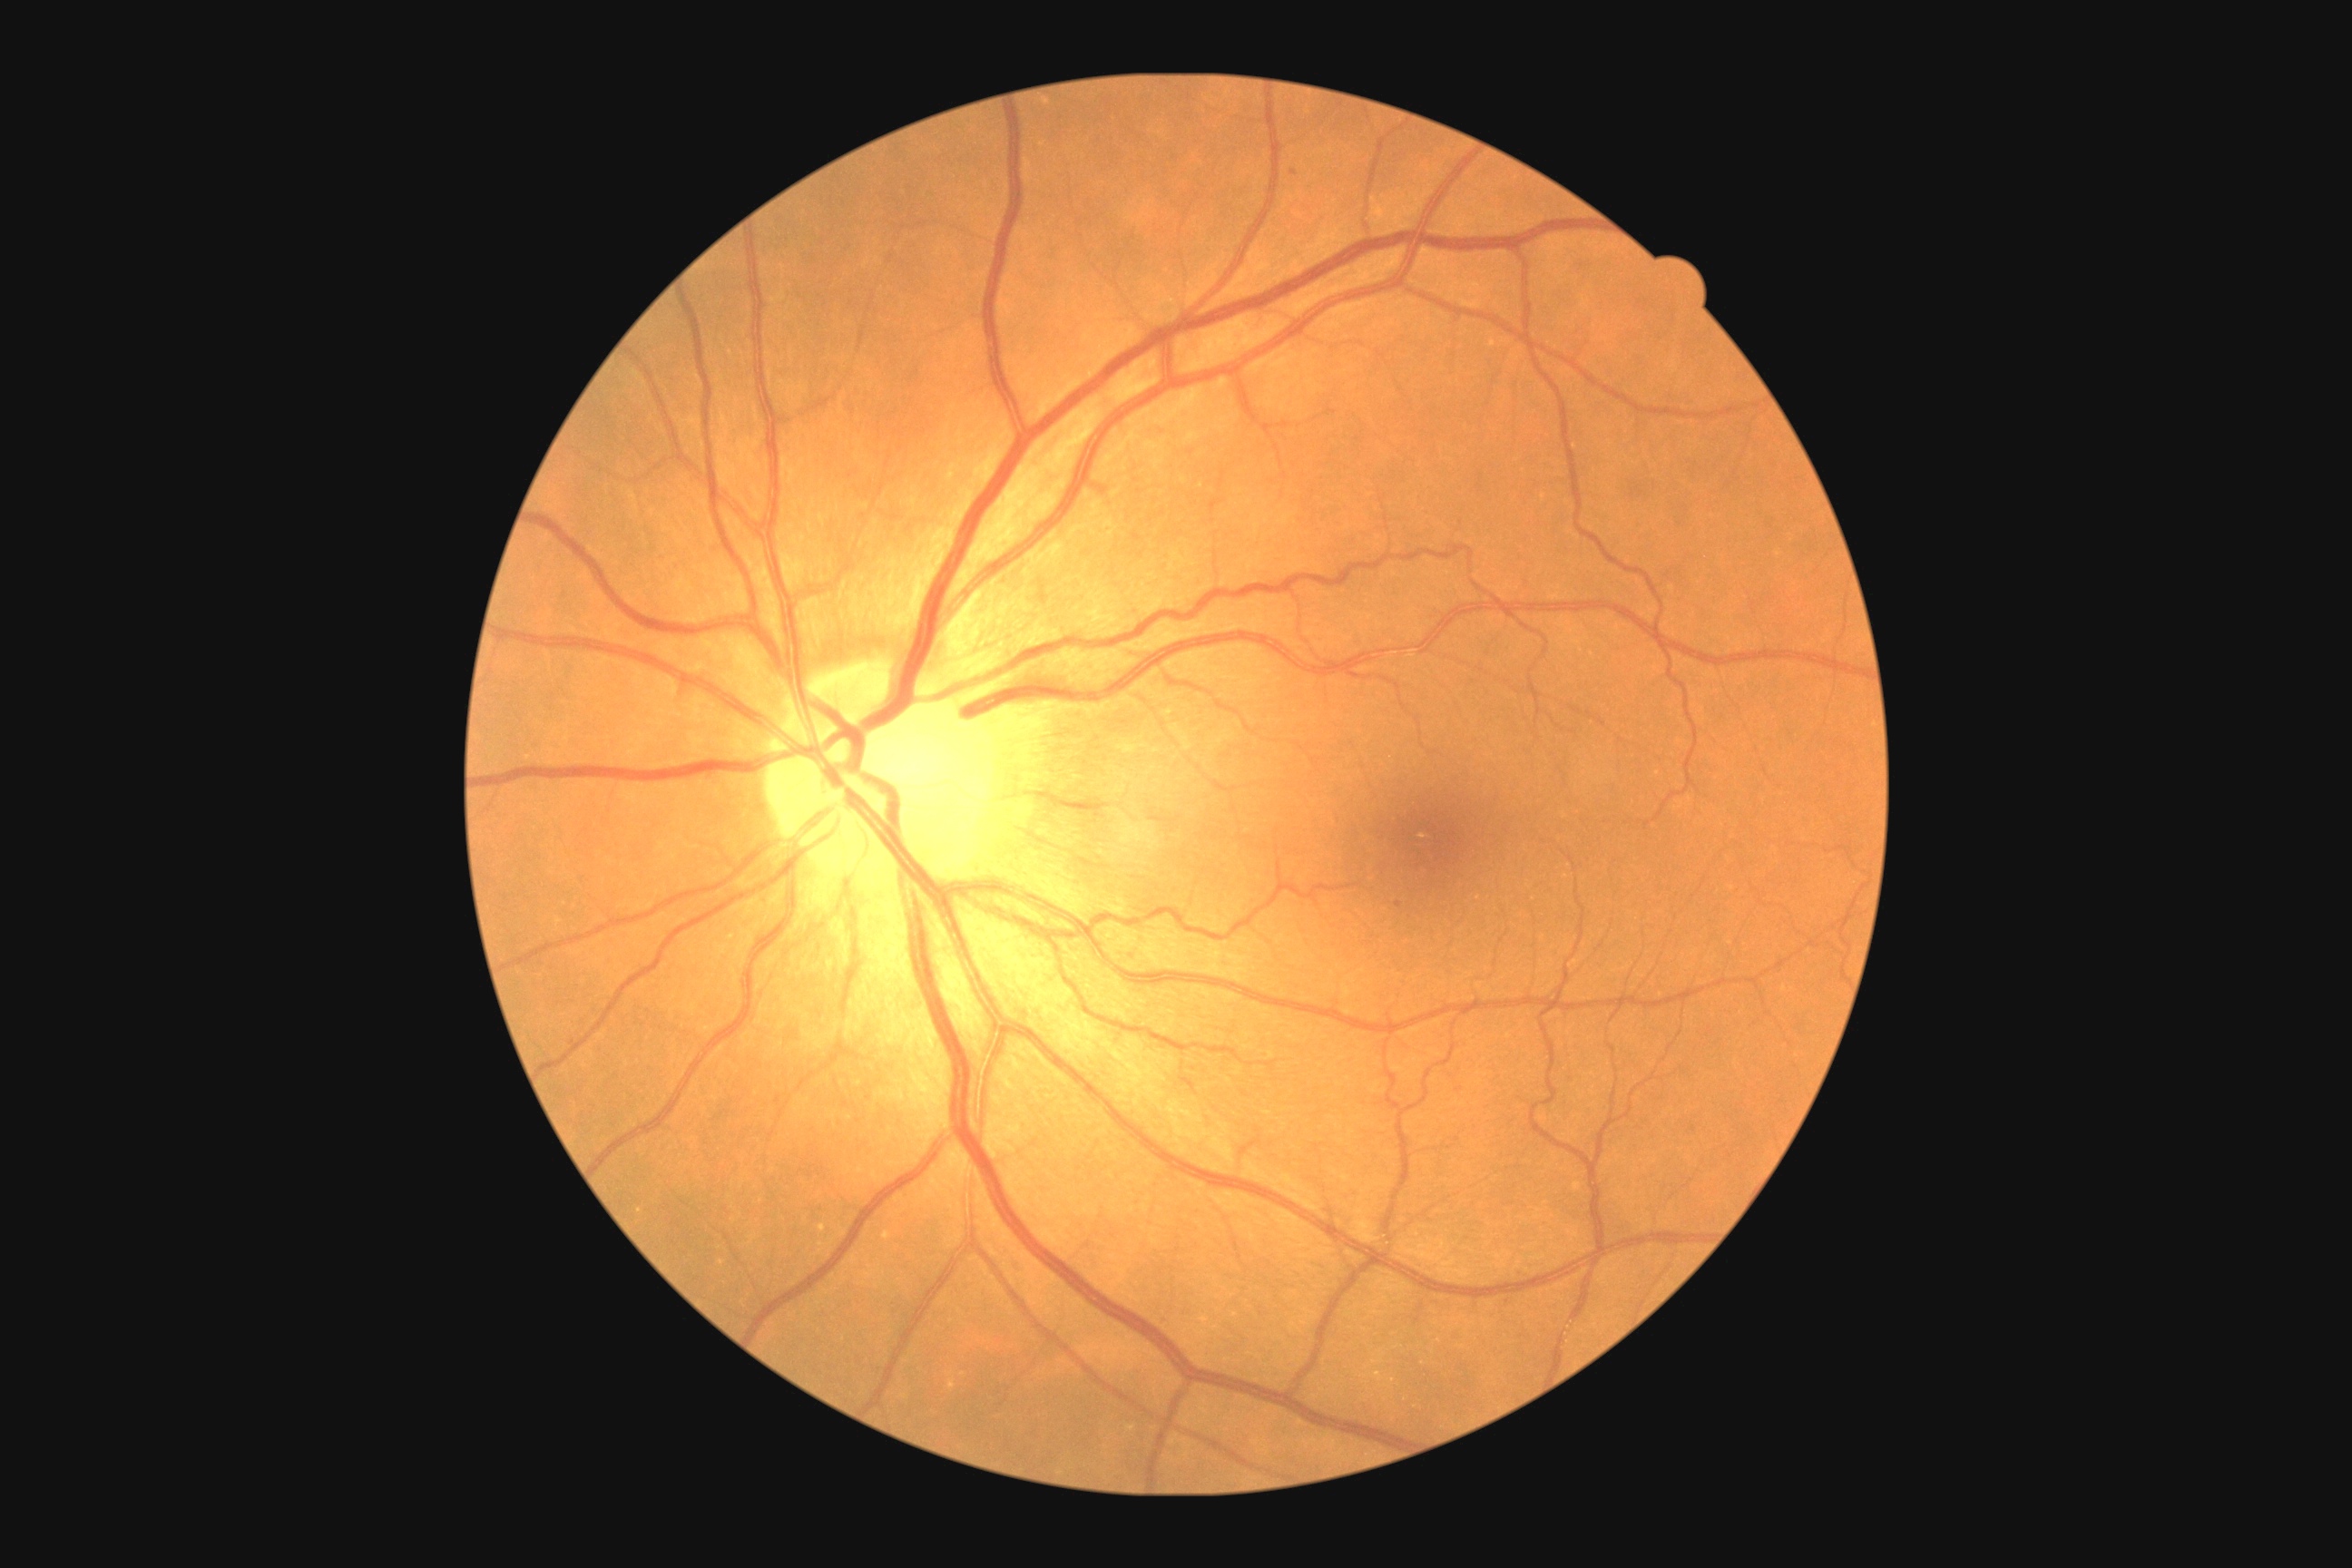 Annotations:
* diabetic retinopathy grade: mild non-proliferative diabetic retinopathy (1)